Davis DR grading, NIDEK AFC-230 fundus camera, image size 848x848 — 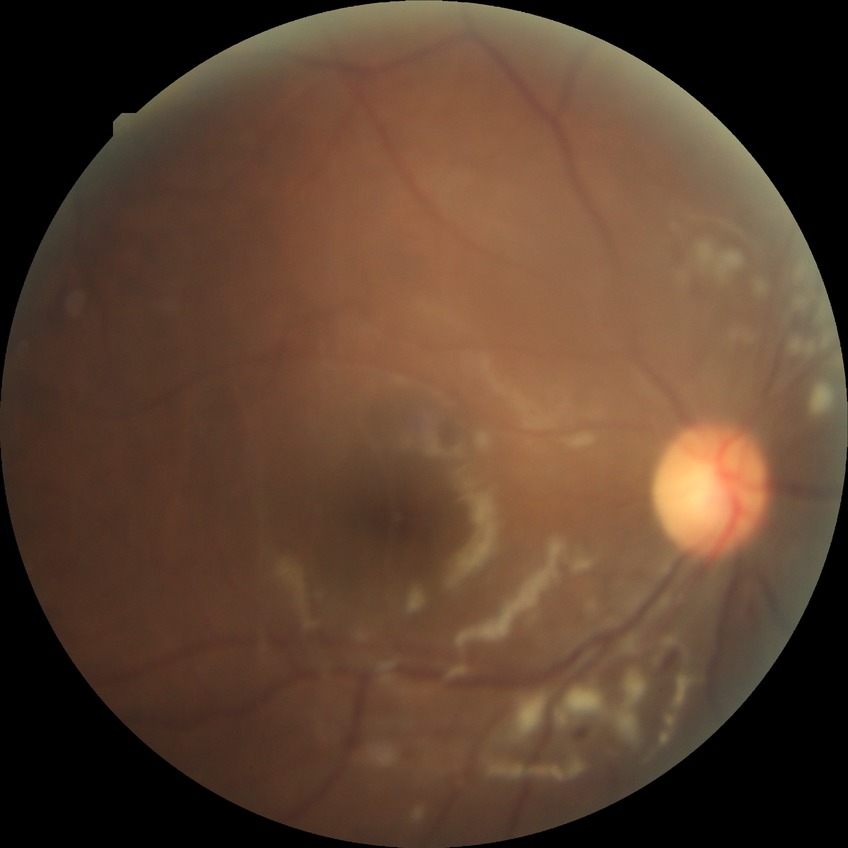 Diabetic retinopathy grade: pre-proliferative diabetic retinopathy.
The retinopathy is classified as non-proliferative diabetic retinopathy.